Optic disc photograph:
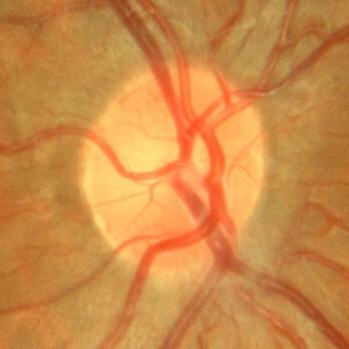 Glaucoma assessment = no glaucomatous changes.